Tabletop color fundus camera image
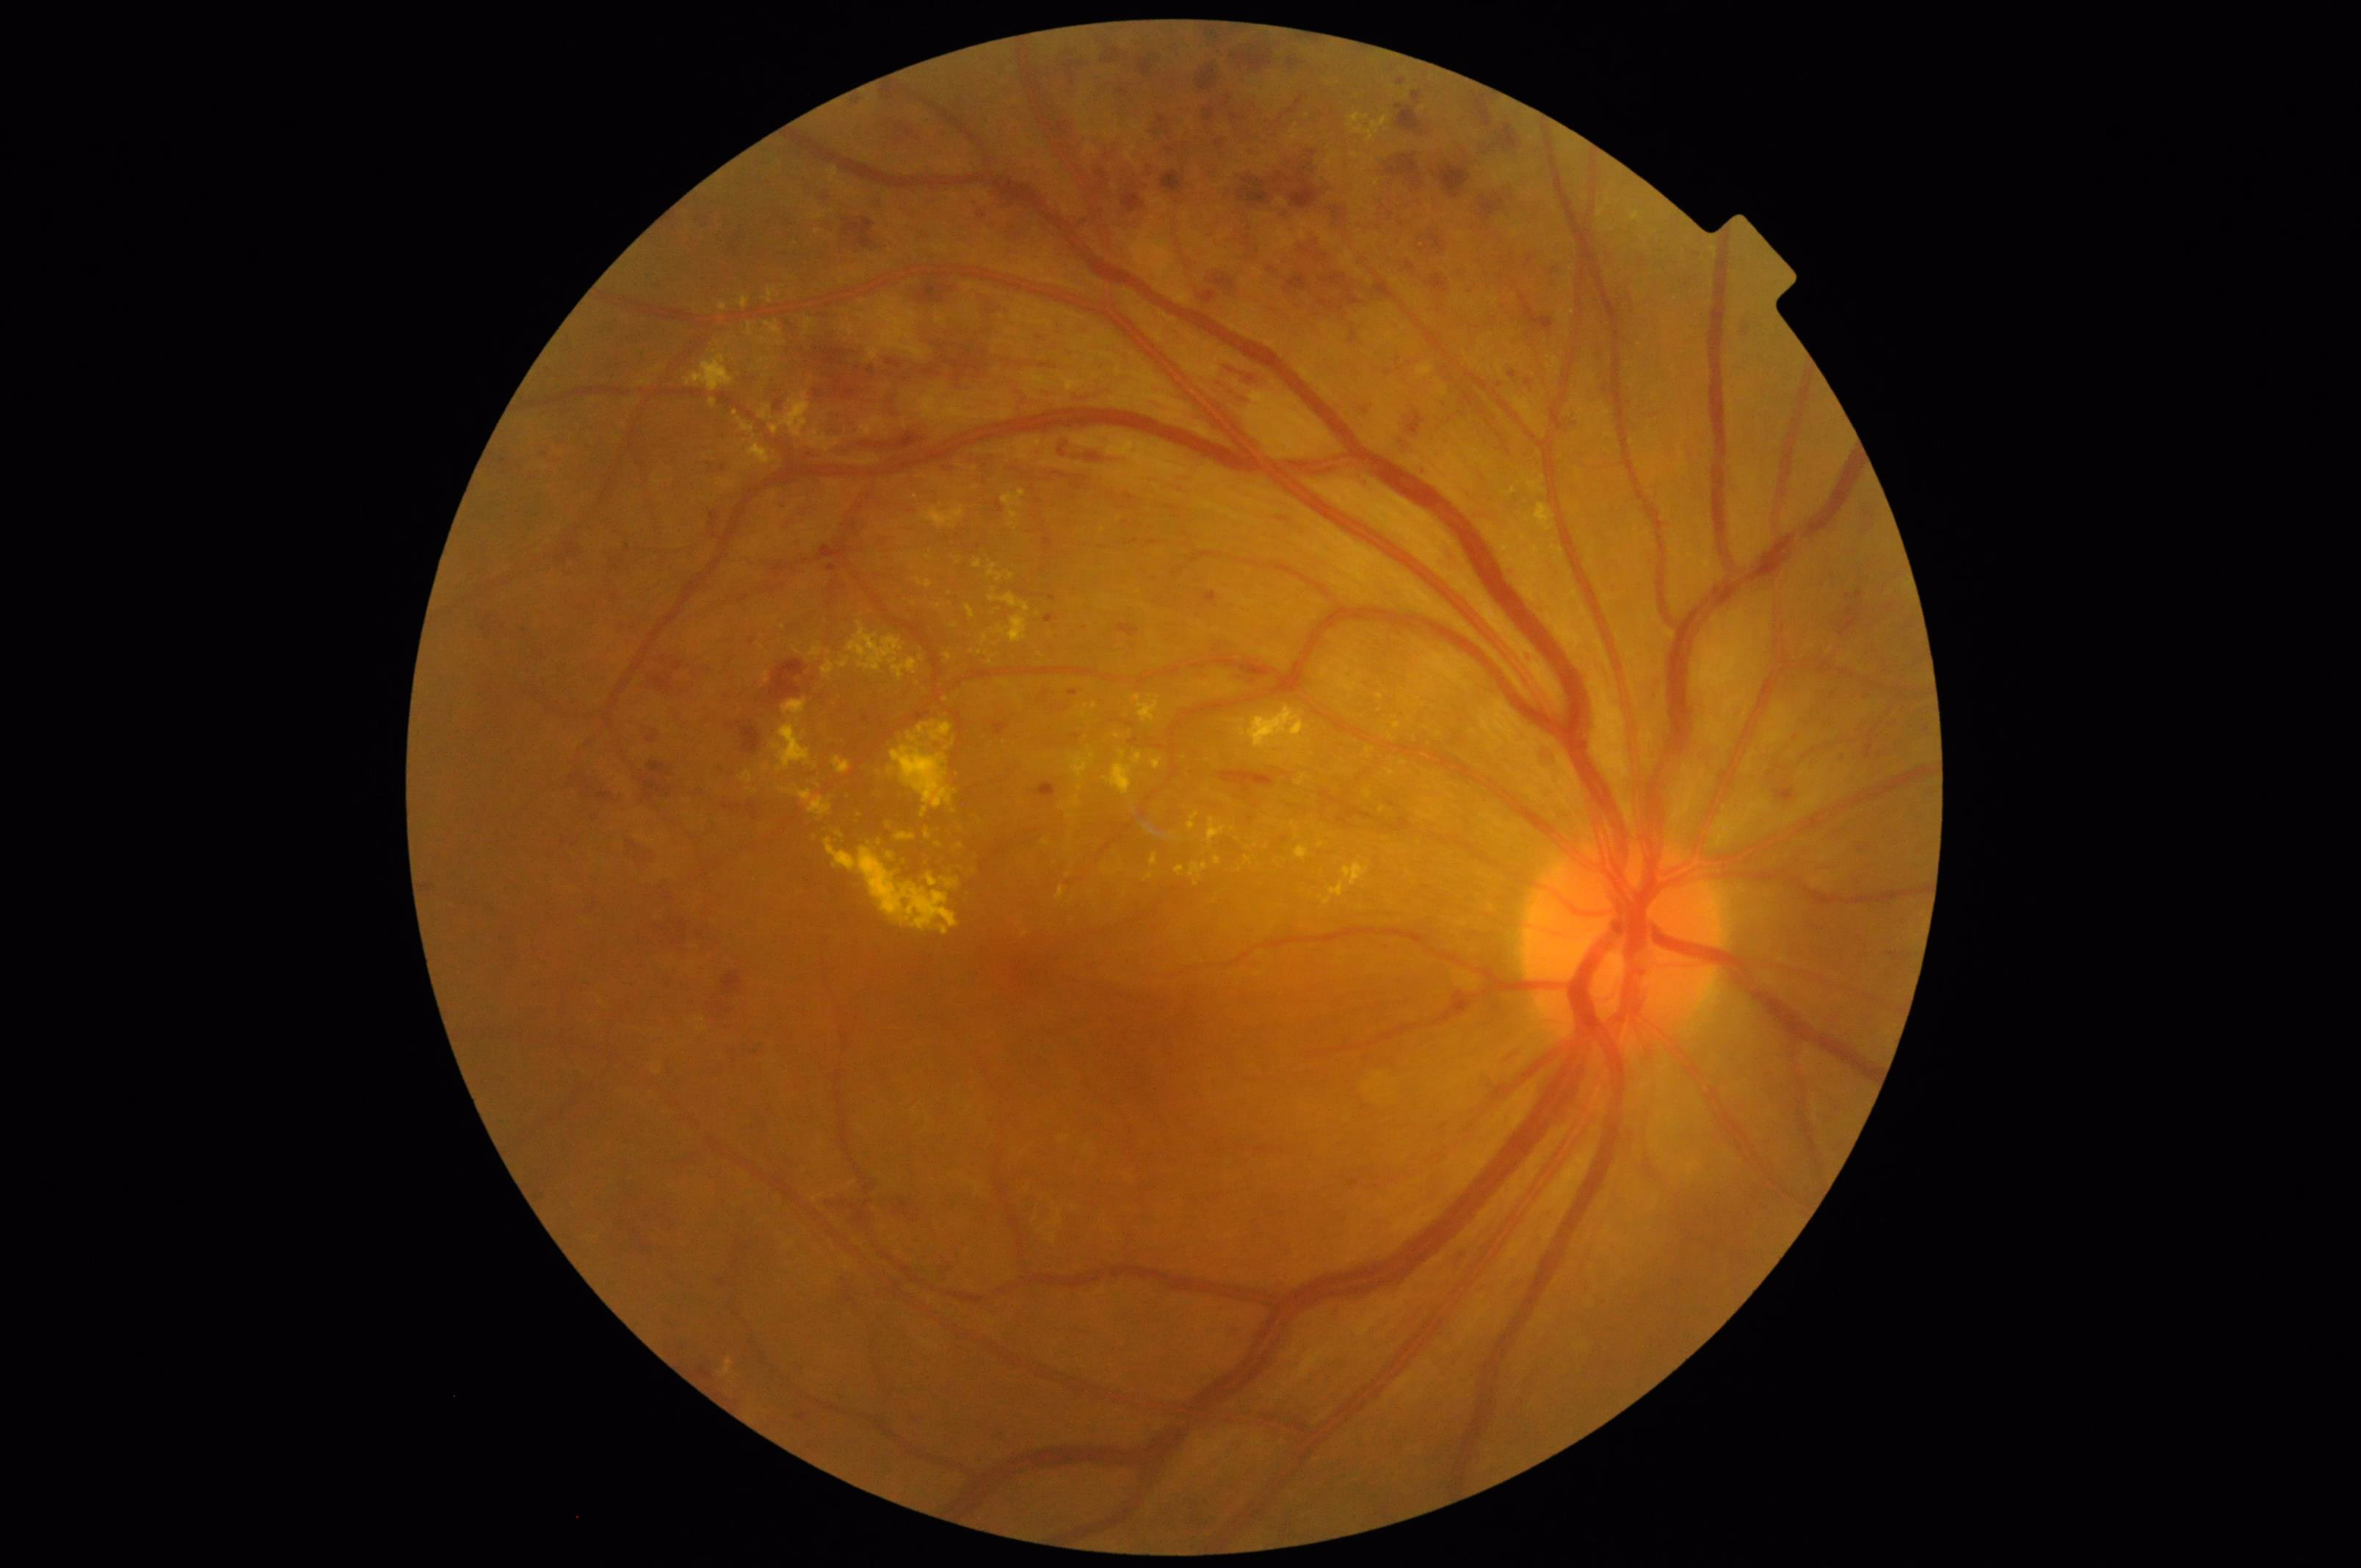

Even illumination with no color cast.
Image quality is adequate for diagnostic use.
Good dynamic range.